Diabetic retinopathy graded by the modified Davis classification. Acquired with a NIDEK AFC-230. 45° FOV:
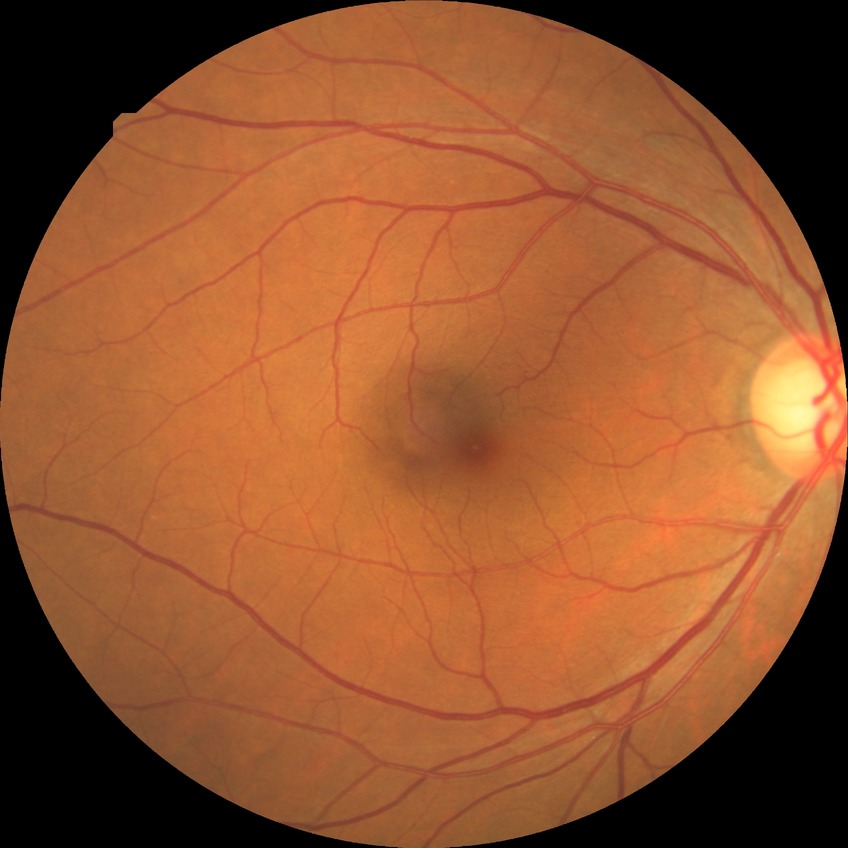 Davis grading: no diabetic retinopathy.